848 by 848 pixels, 45 degree fundus photograph, modified Davis classification.
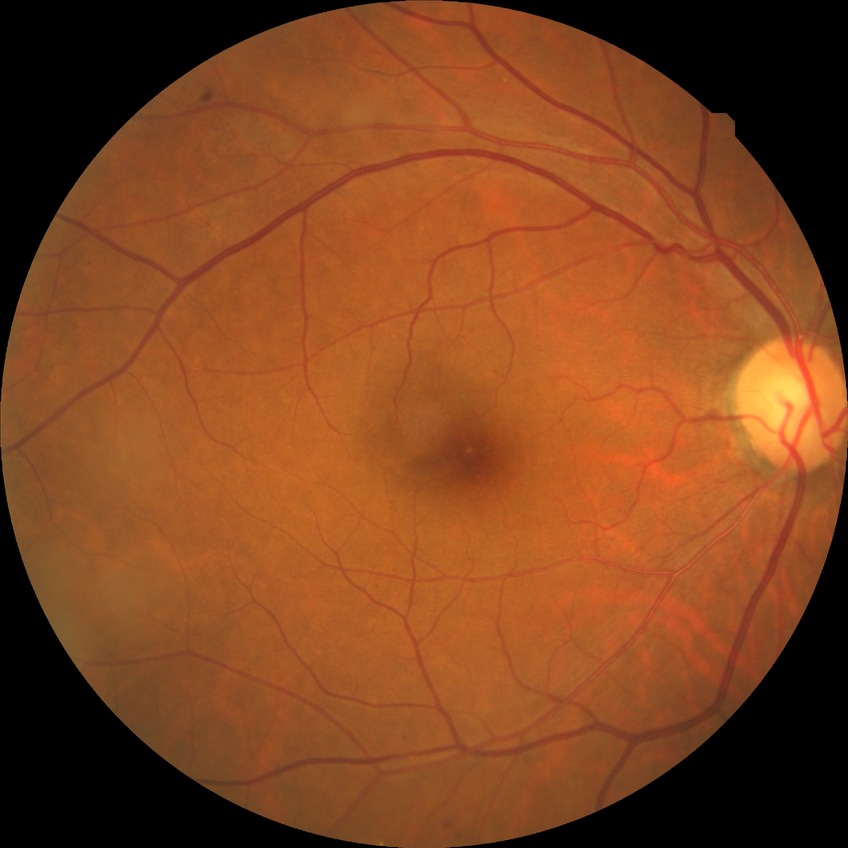

diabetic retinopathy (DR): SDR (simple diabetic retinopathy).